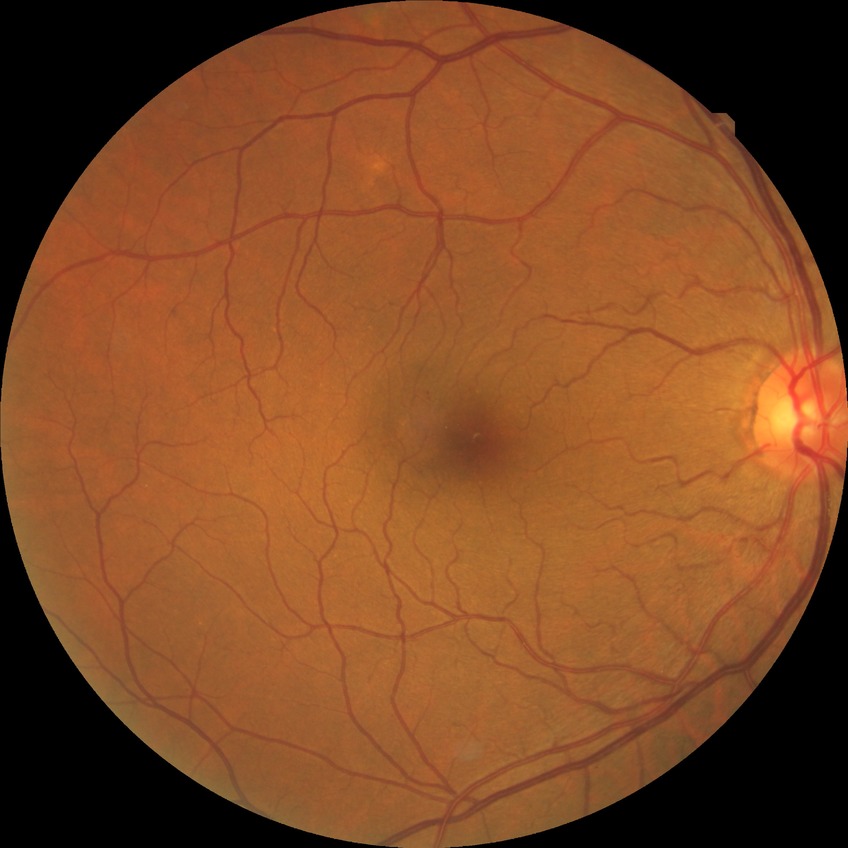 {"davis_grade": "no diabetic retinopathy (NDR)"}